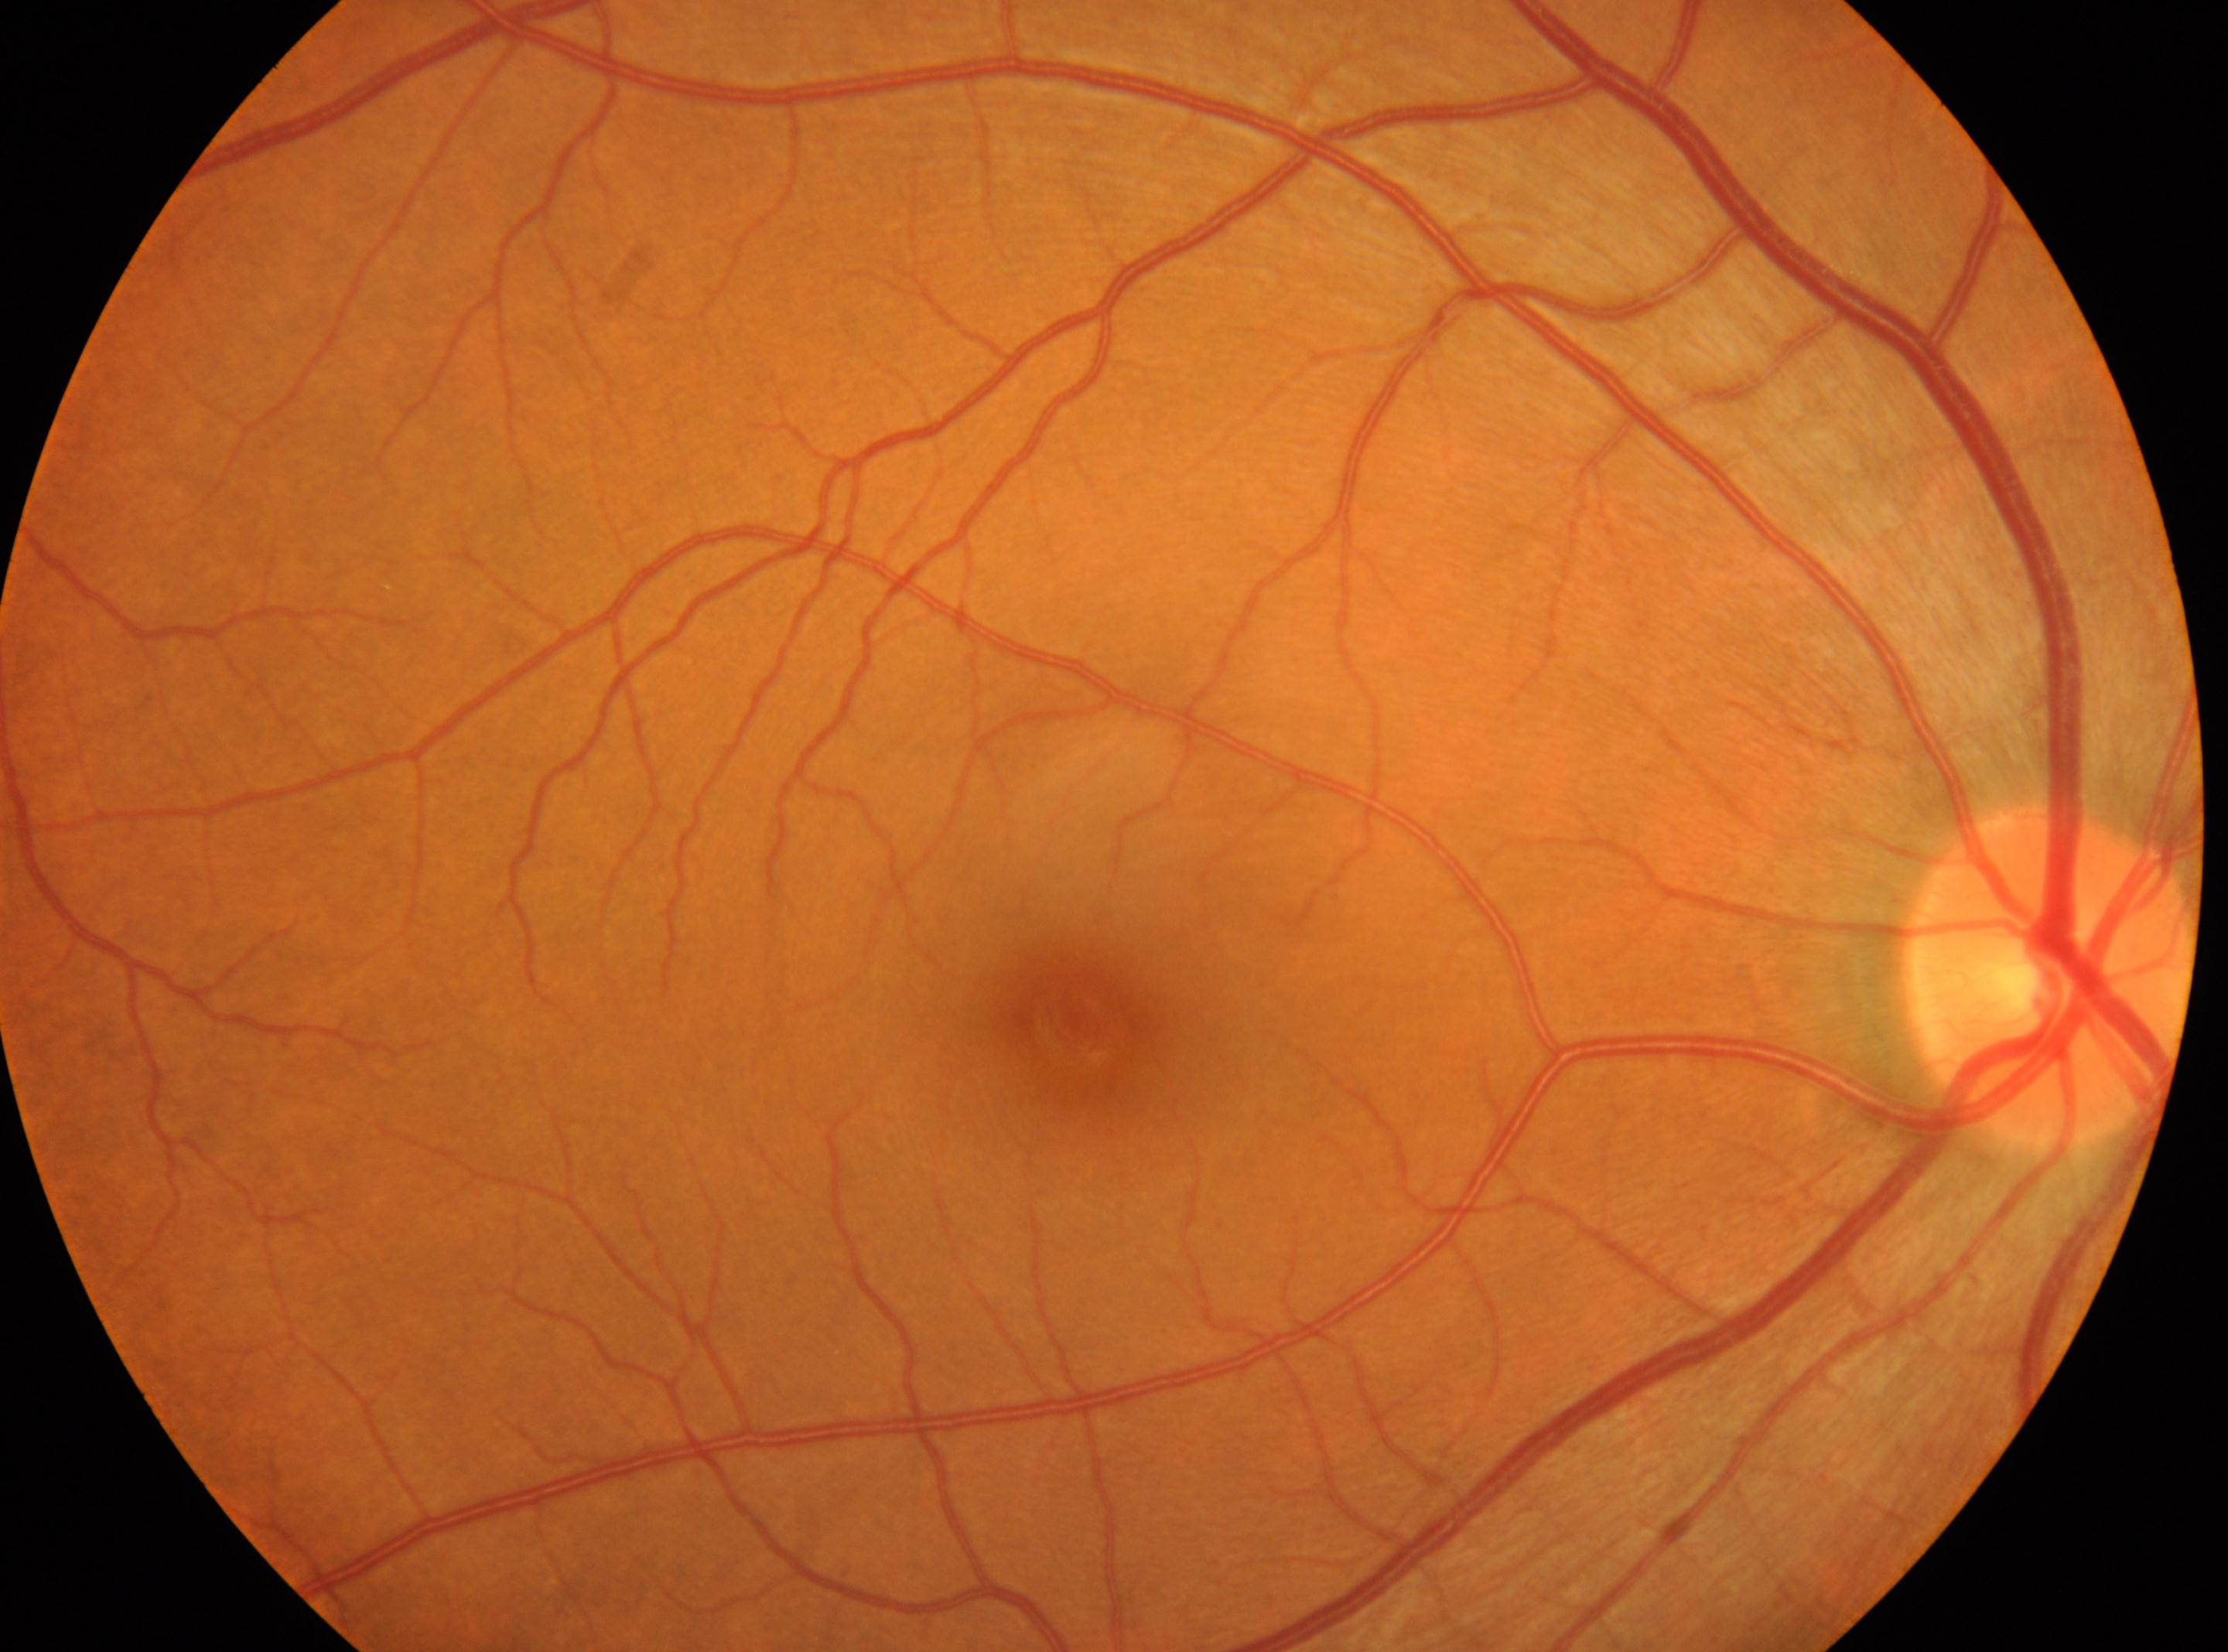
This is the oculus dexter.
DR stage: no apparent retinopathy (grade 0).
Fovea located at (1078,1024).
No diabetic retinopathy identified.
The ONH is at (2052,974).